Infant wide-field fundus photograph
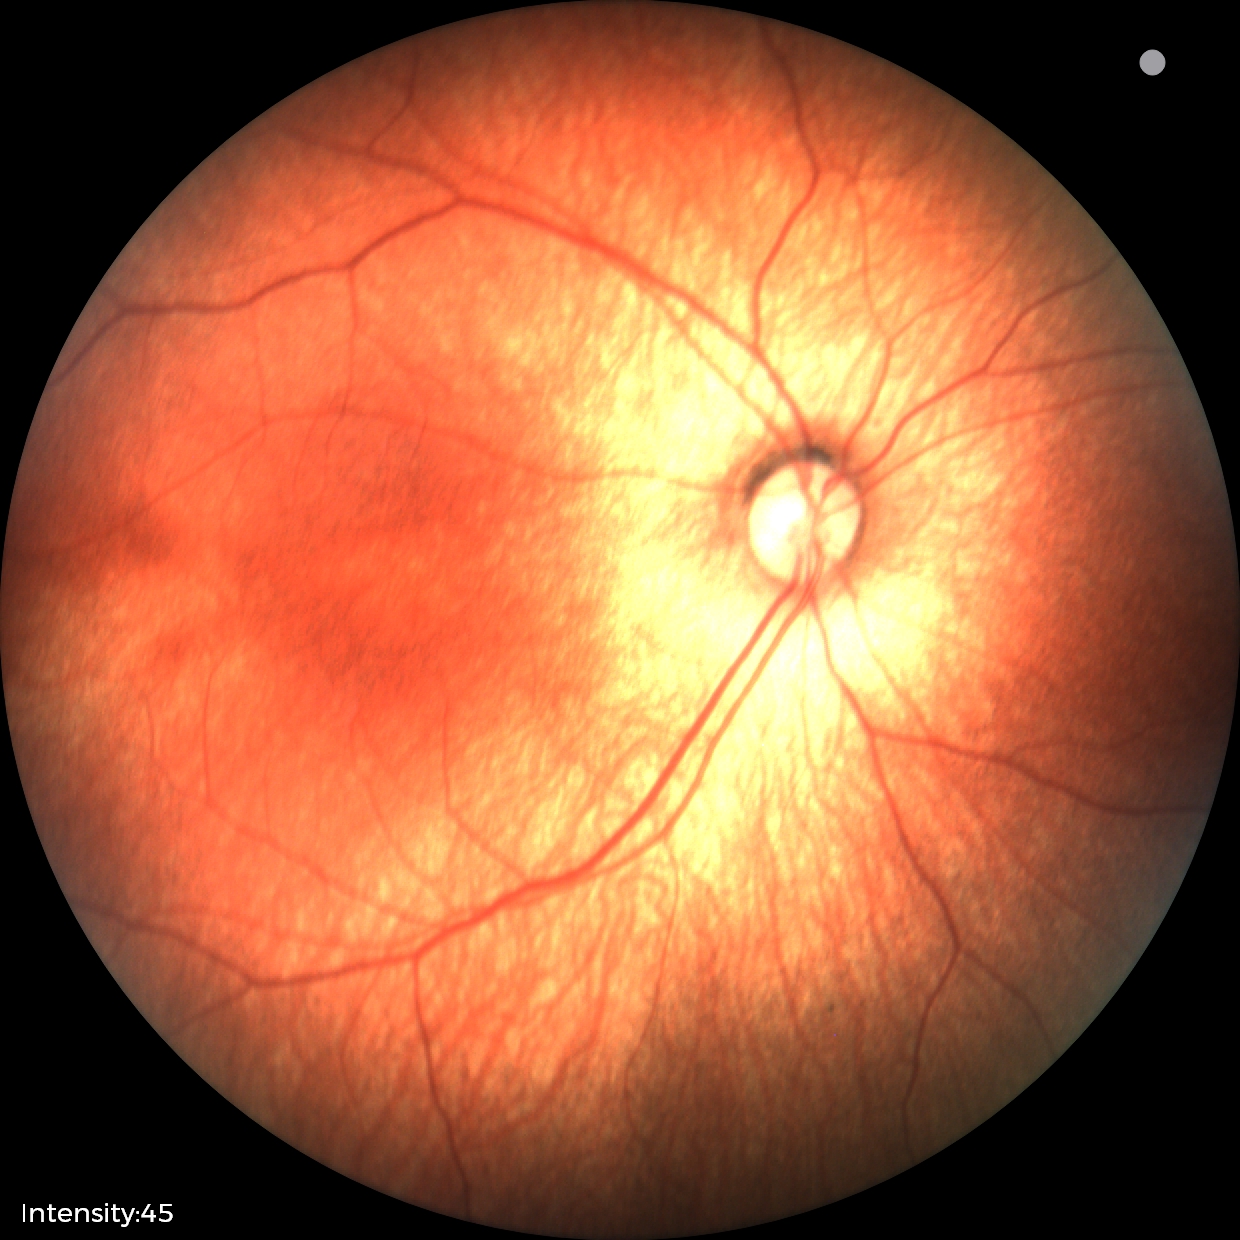 Finding: normal.